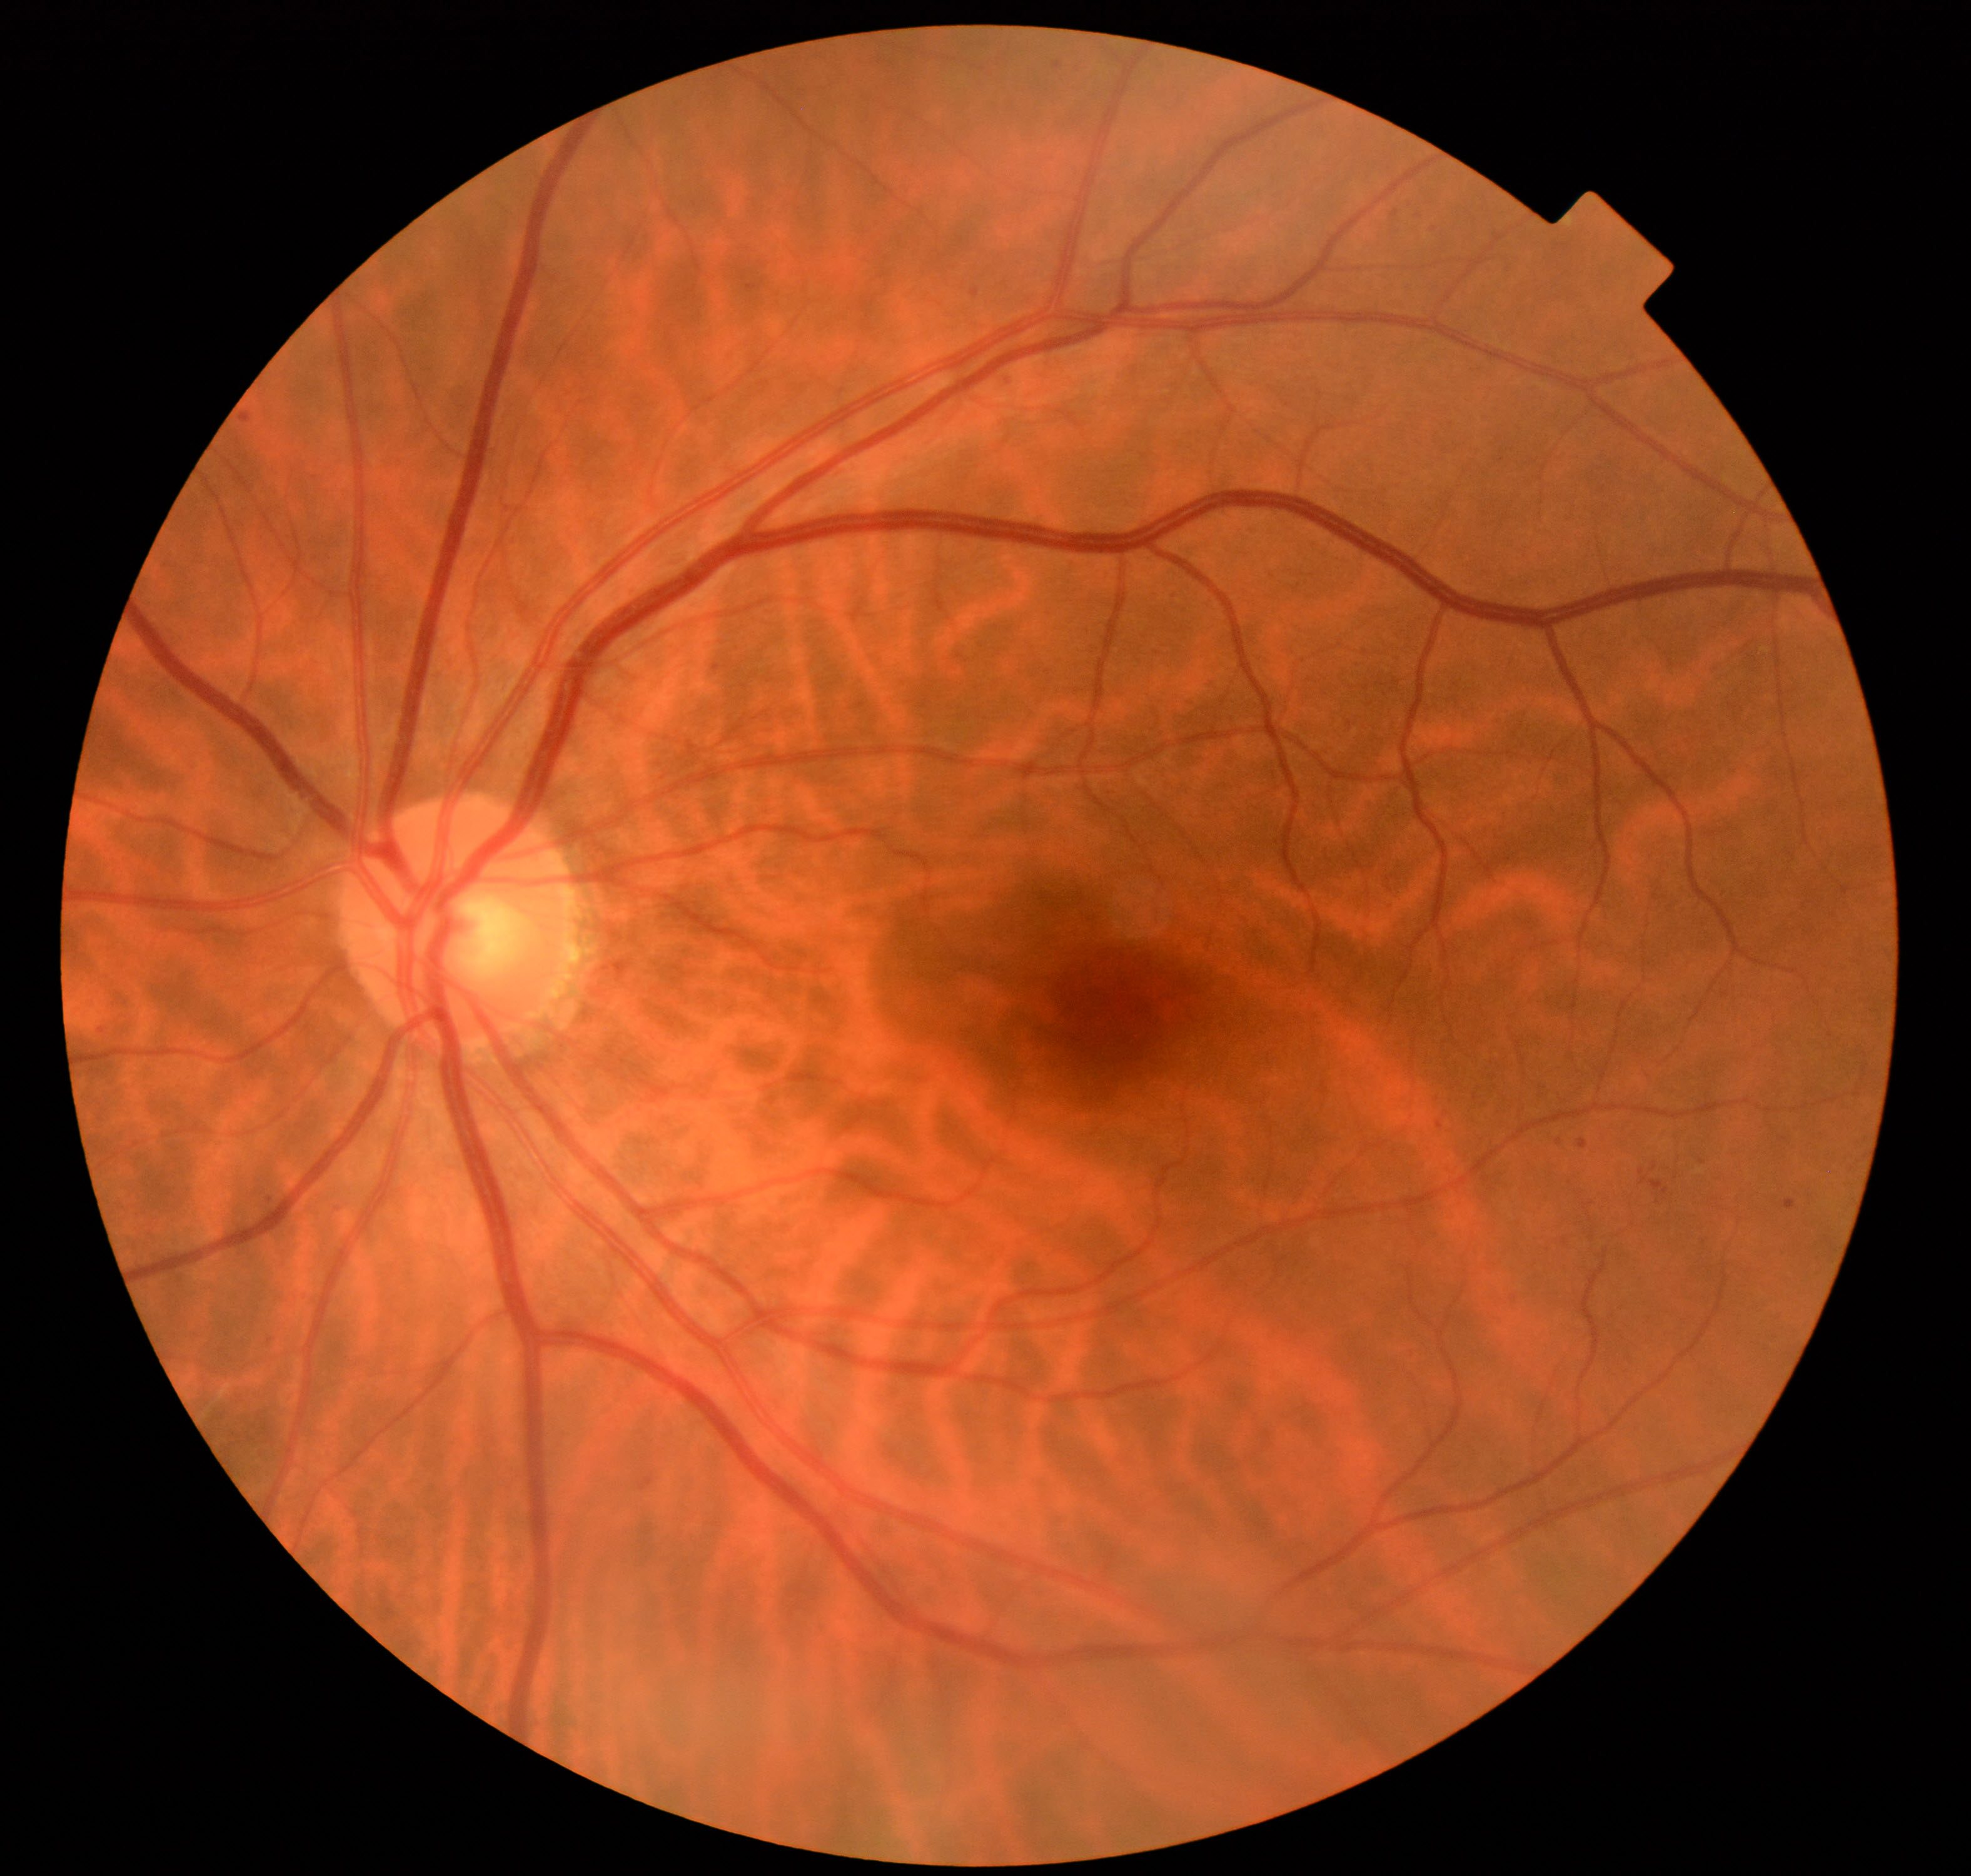

Classification: tessellated fundus.